Nidek AFC-330 · image size 240x240
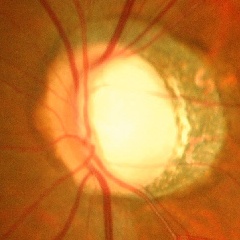 There is evidence of severe glaucomatous damage.